Pediatric retinal photograph (wide-field)
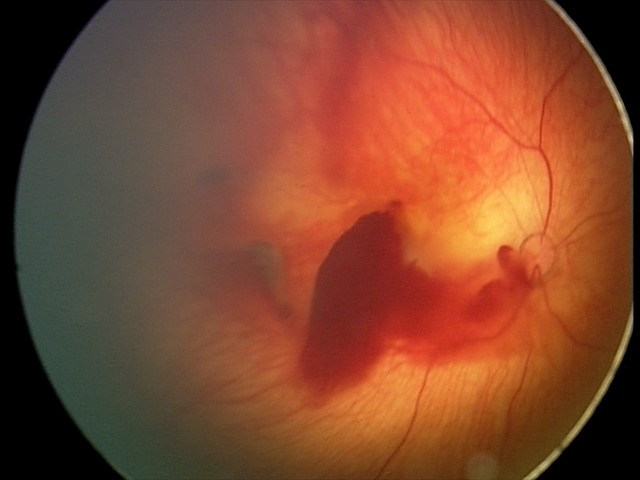 Assessment: retinal hemorrhages.